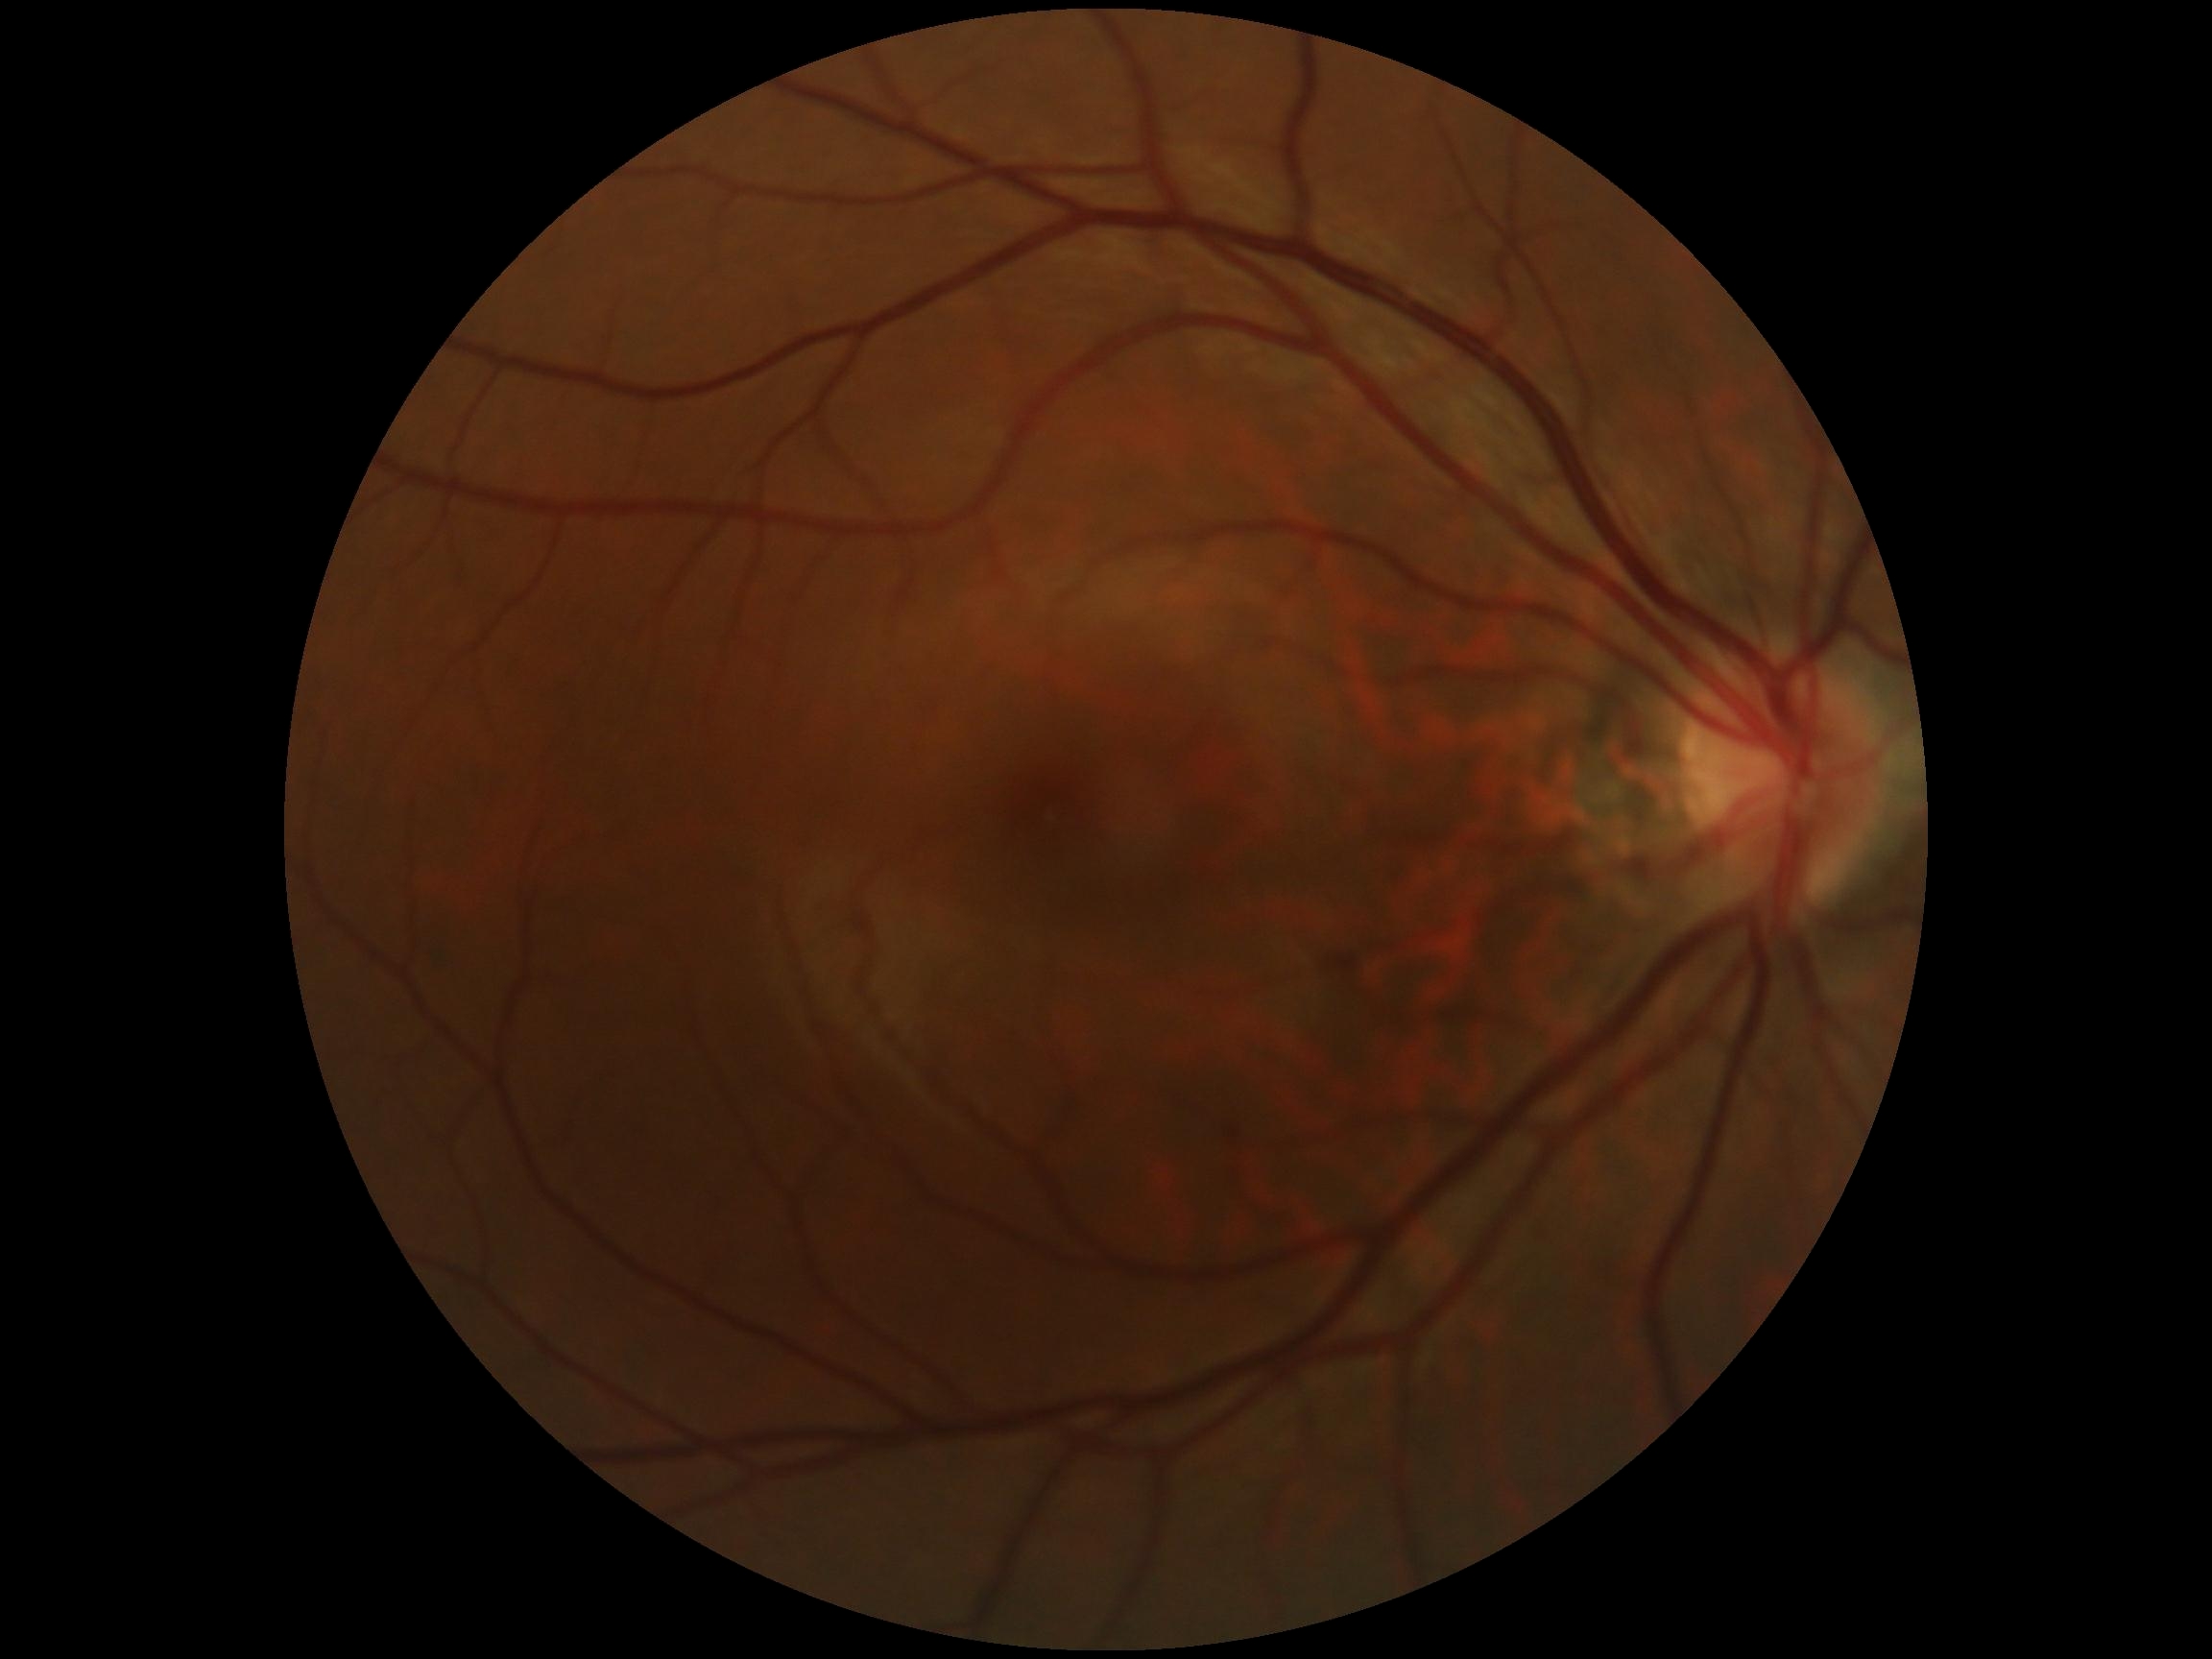 Diabetic retinopathy (DR): grade 0 (no apparent retinopathy).